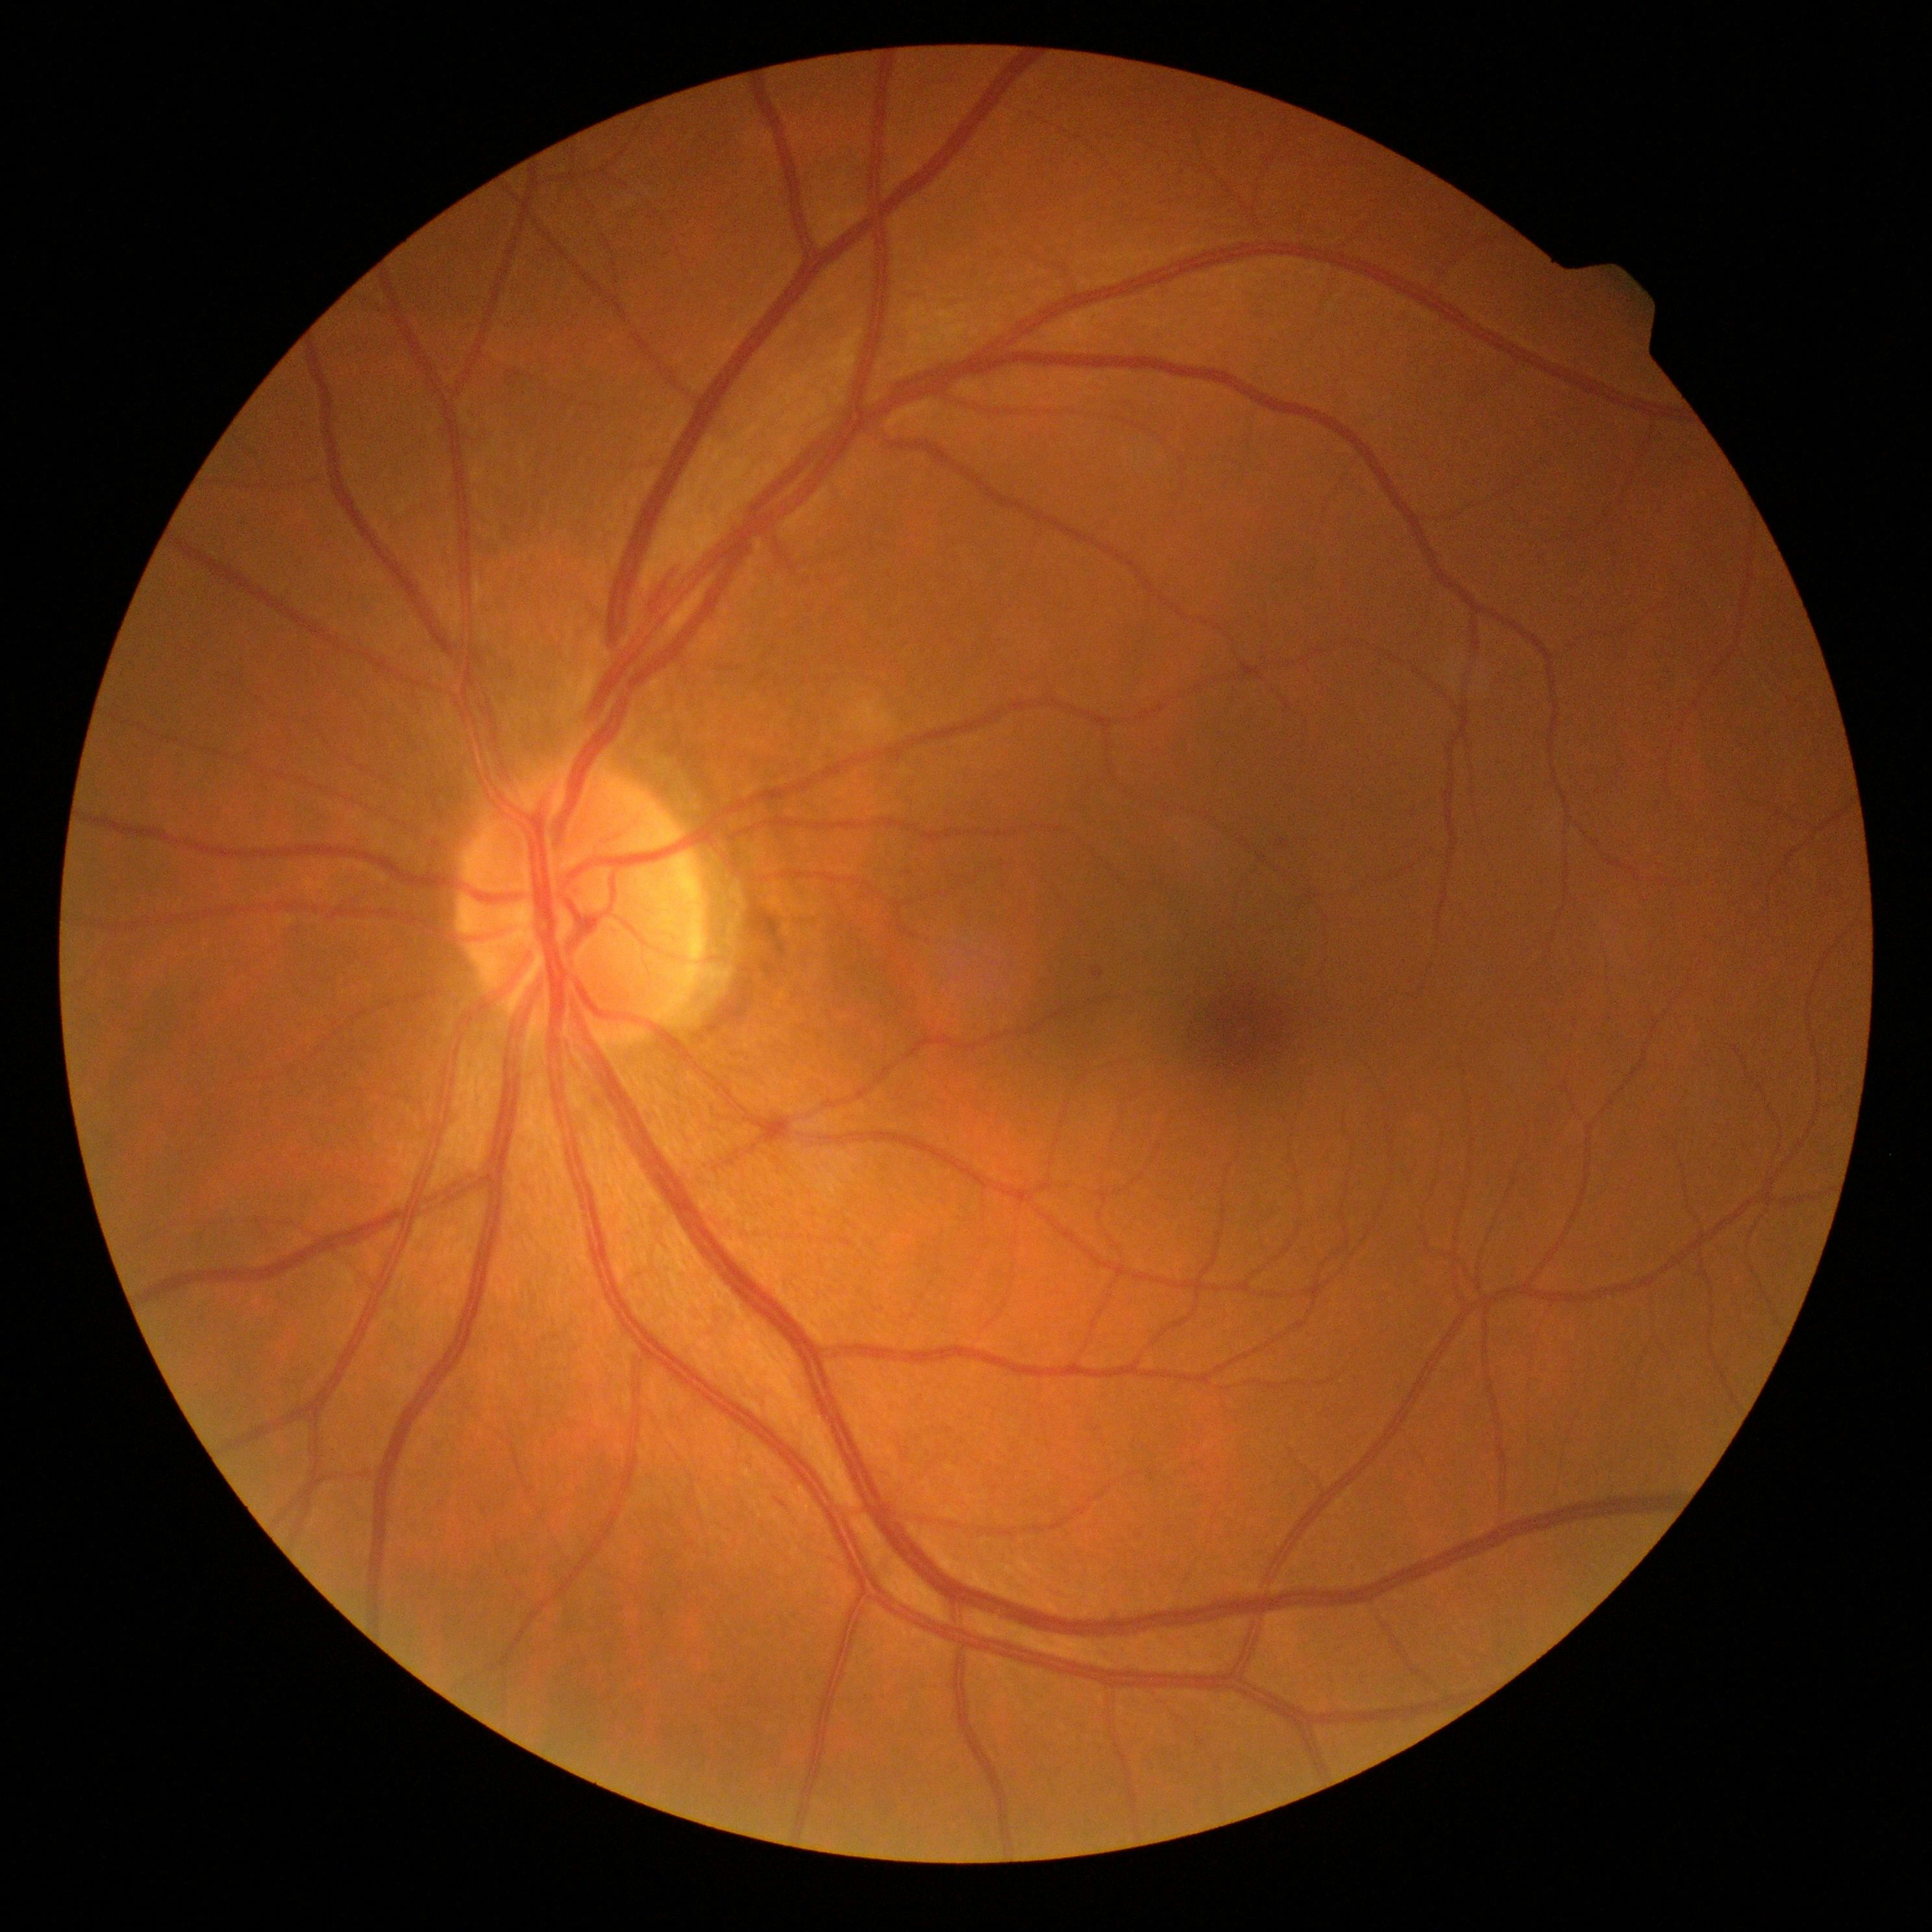 diabetic retinopathy (DR): grade 1 (mild NPDR).